Disc-centered fundus crop; camera: Topcon TRC
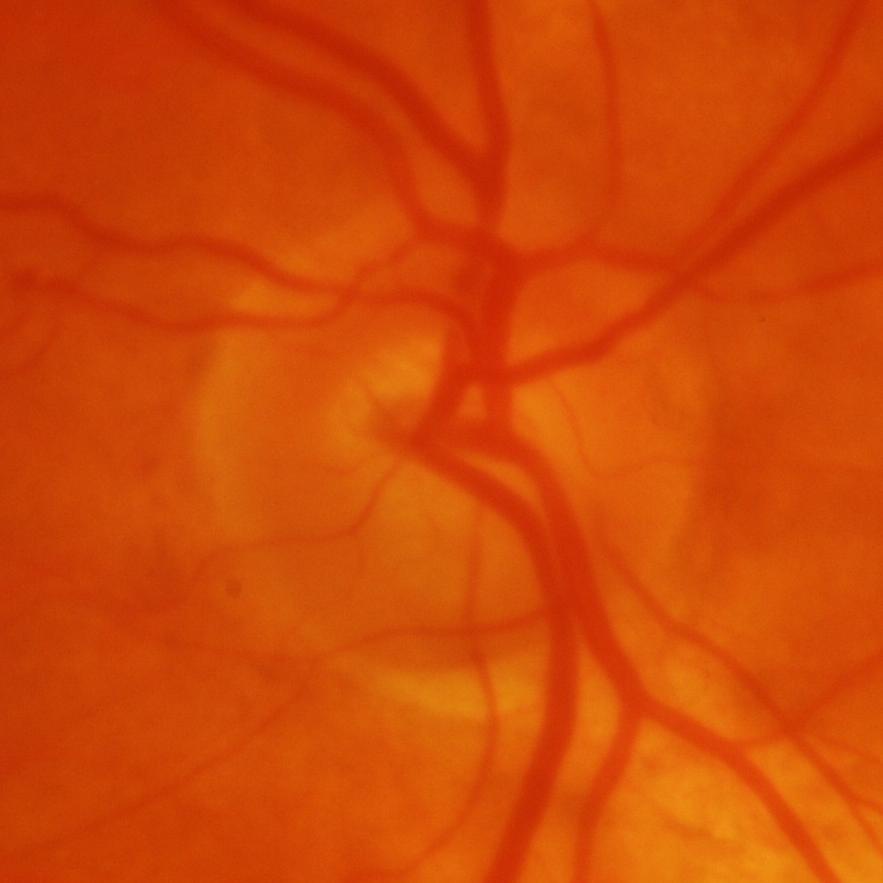 Glaucomatous optic neuropathy is present.
Glaucomatous changes.